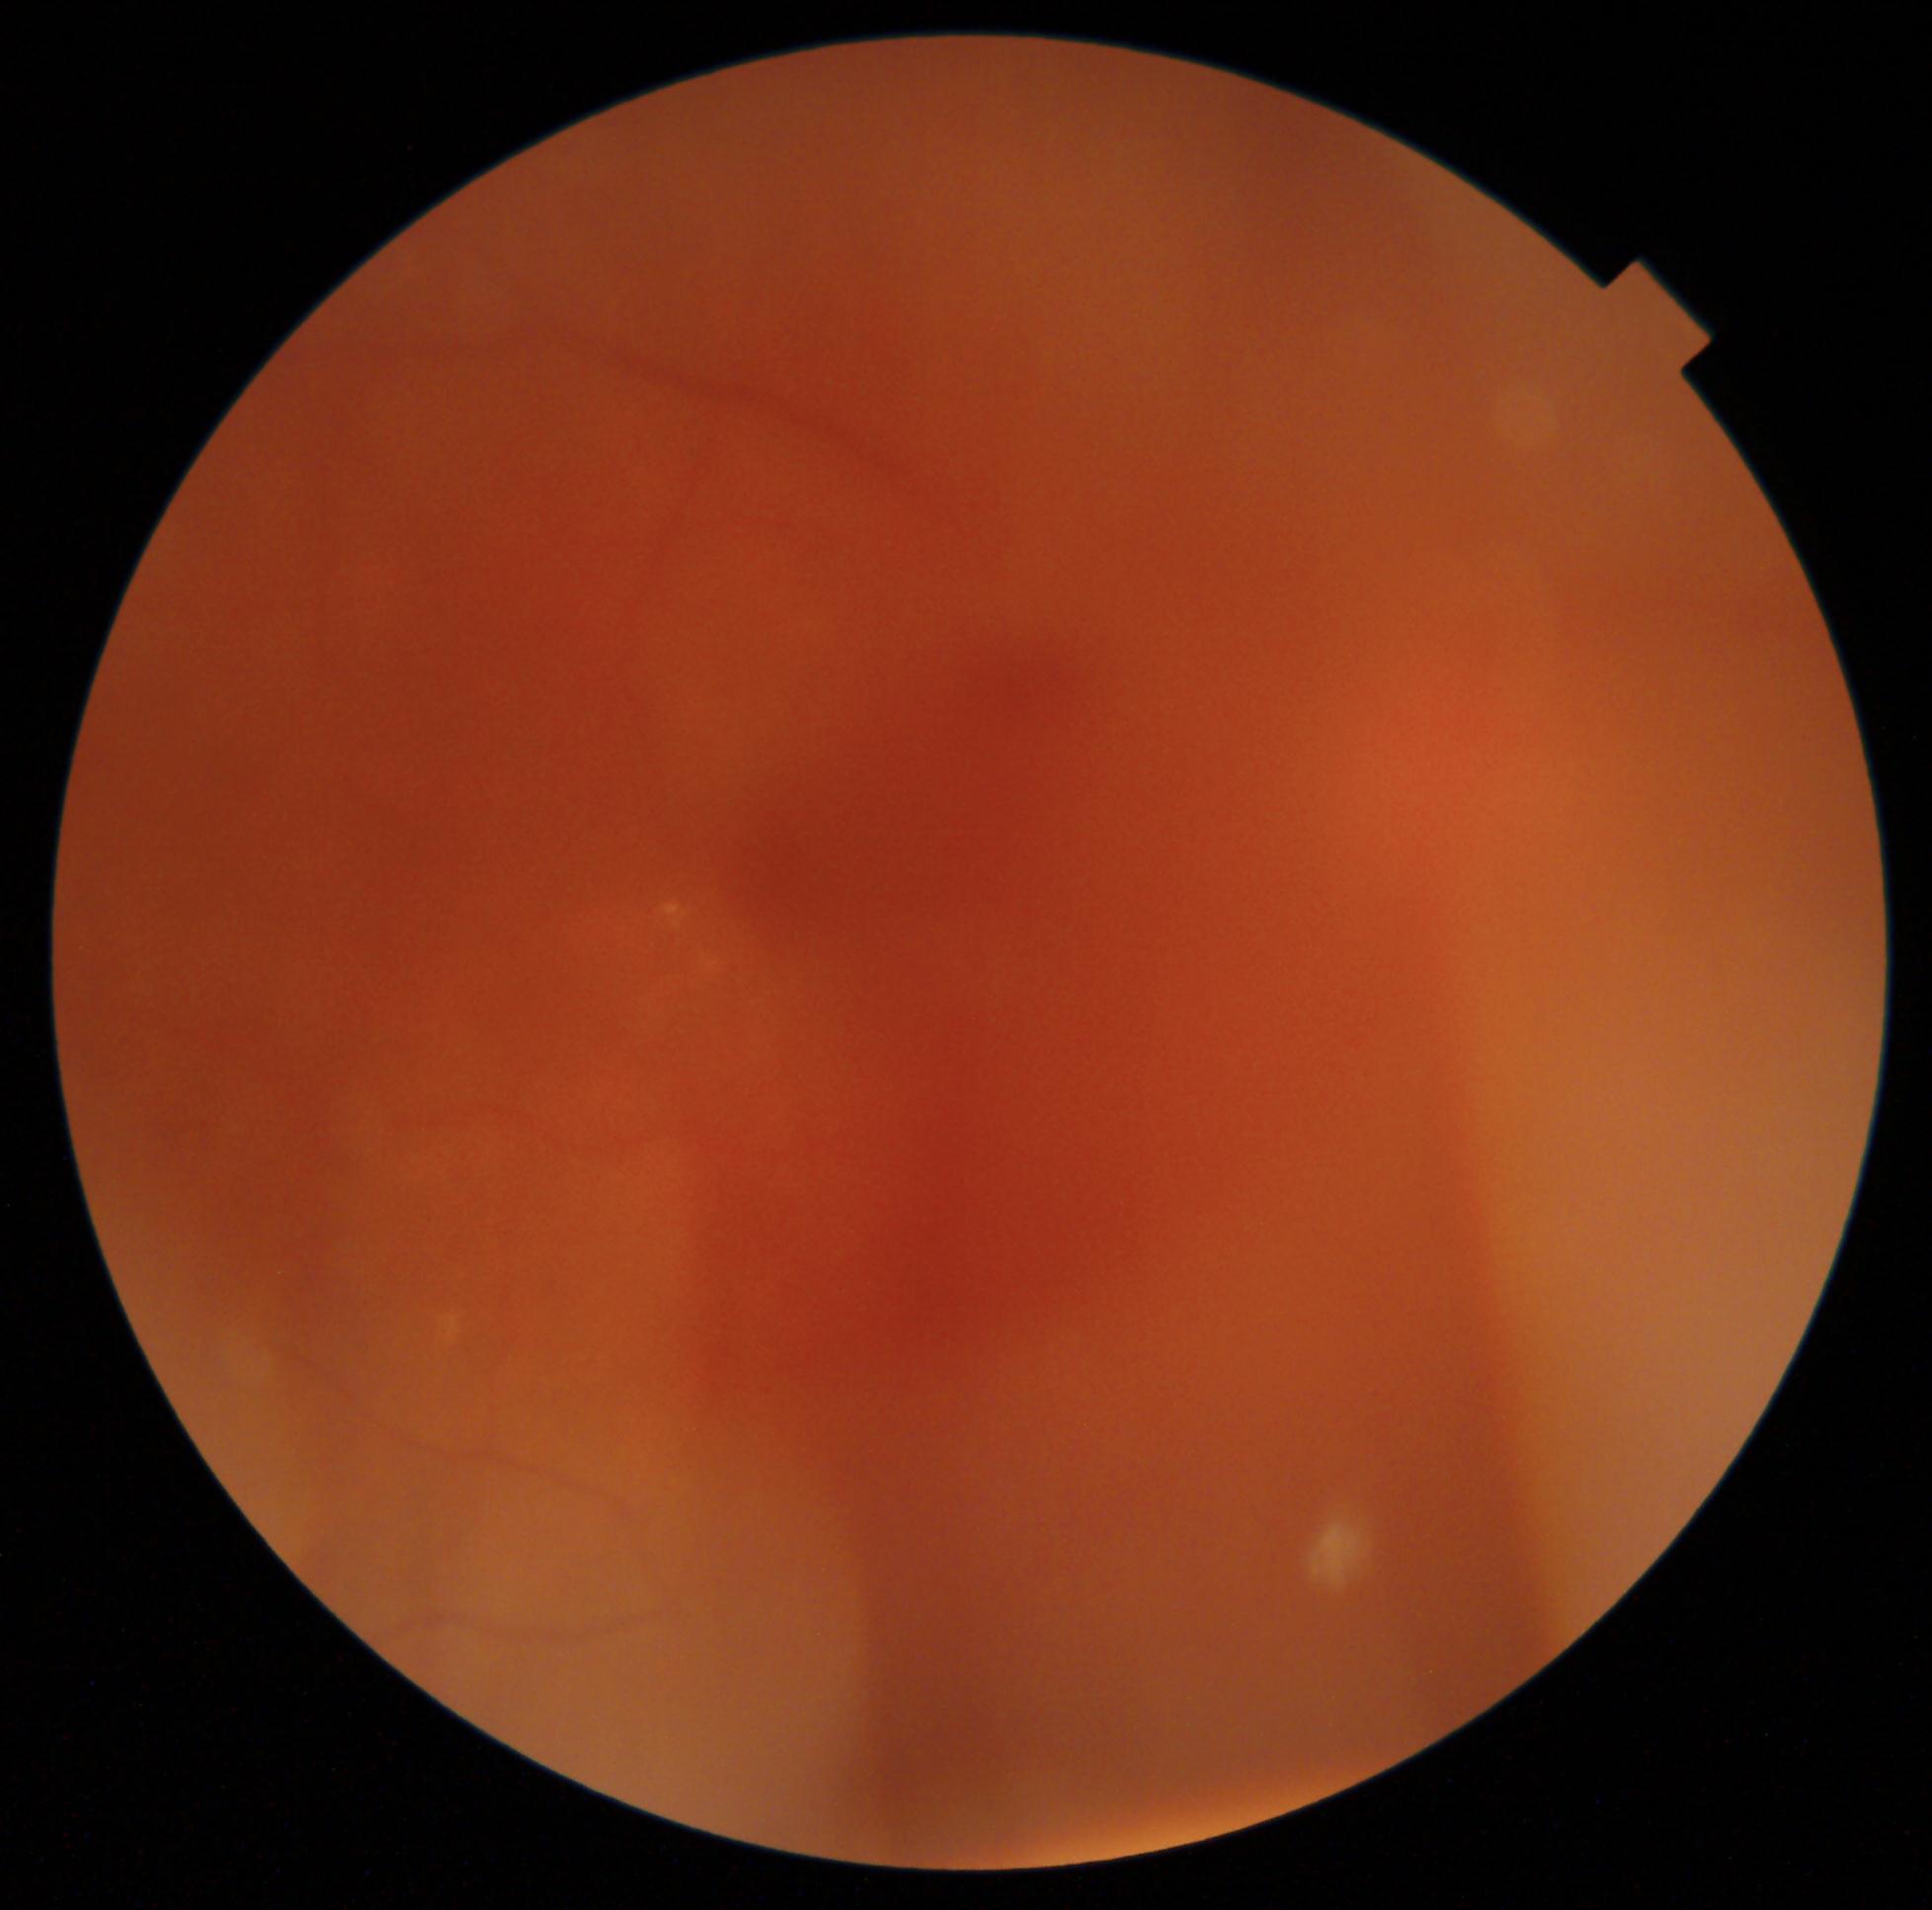 The image cannot be graded for diabetic retinopathy.
Diabetic retinopathy (DR): ungradable due to poor image quality.